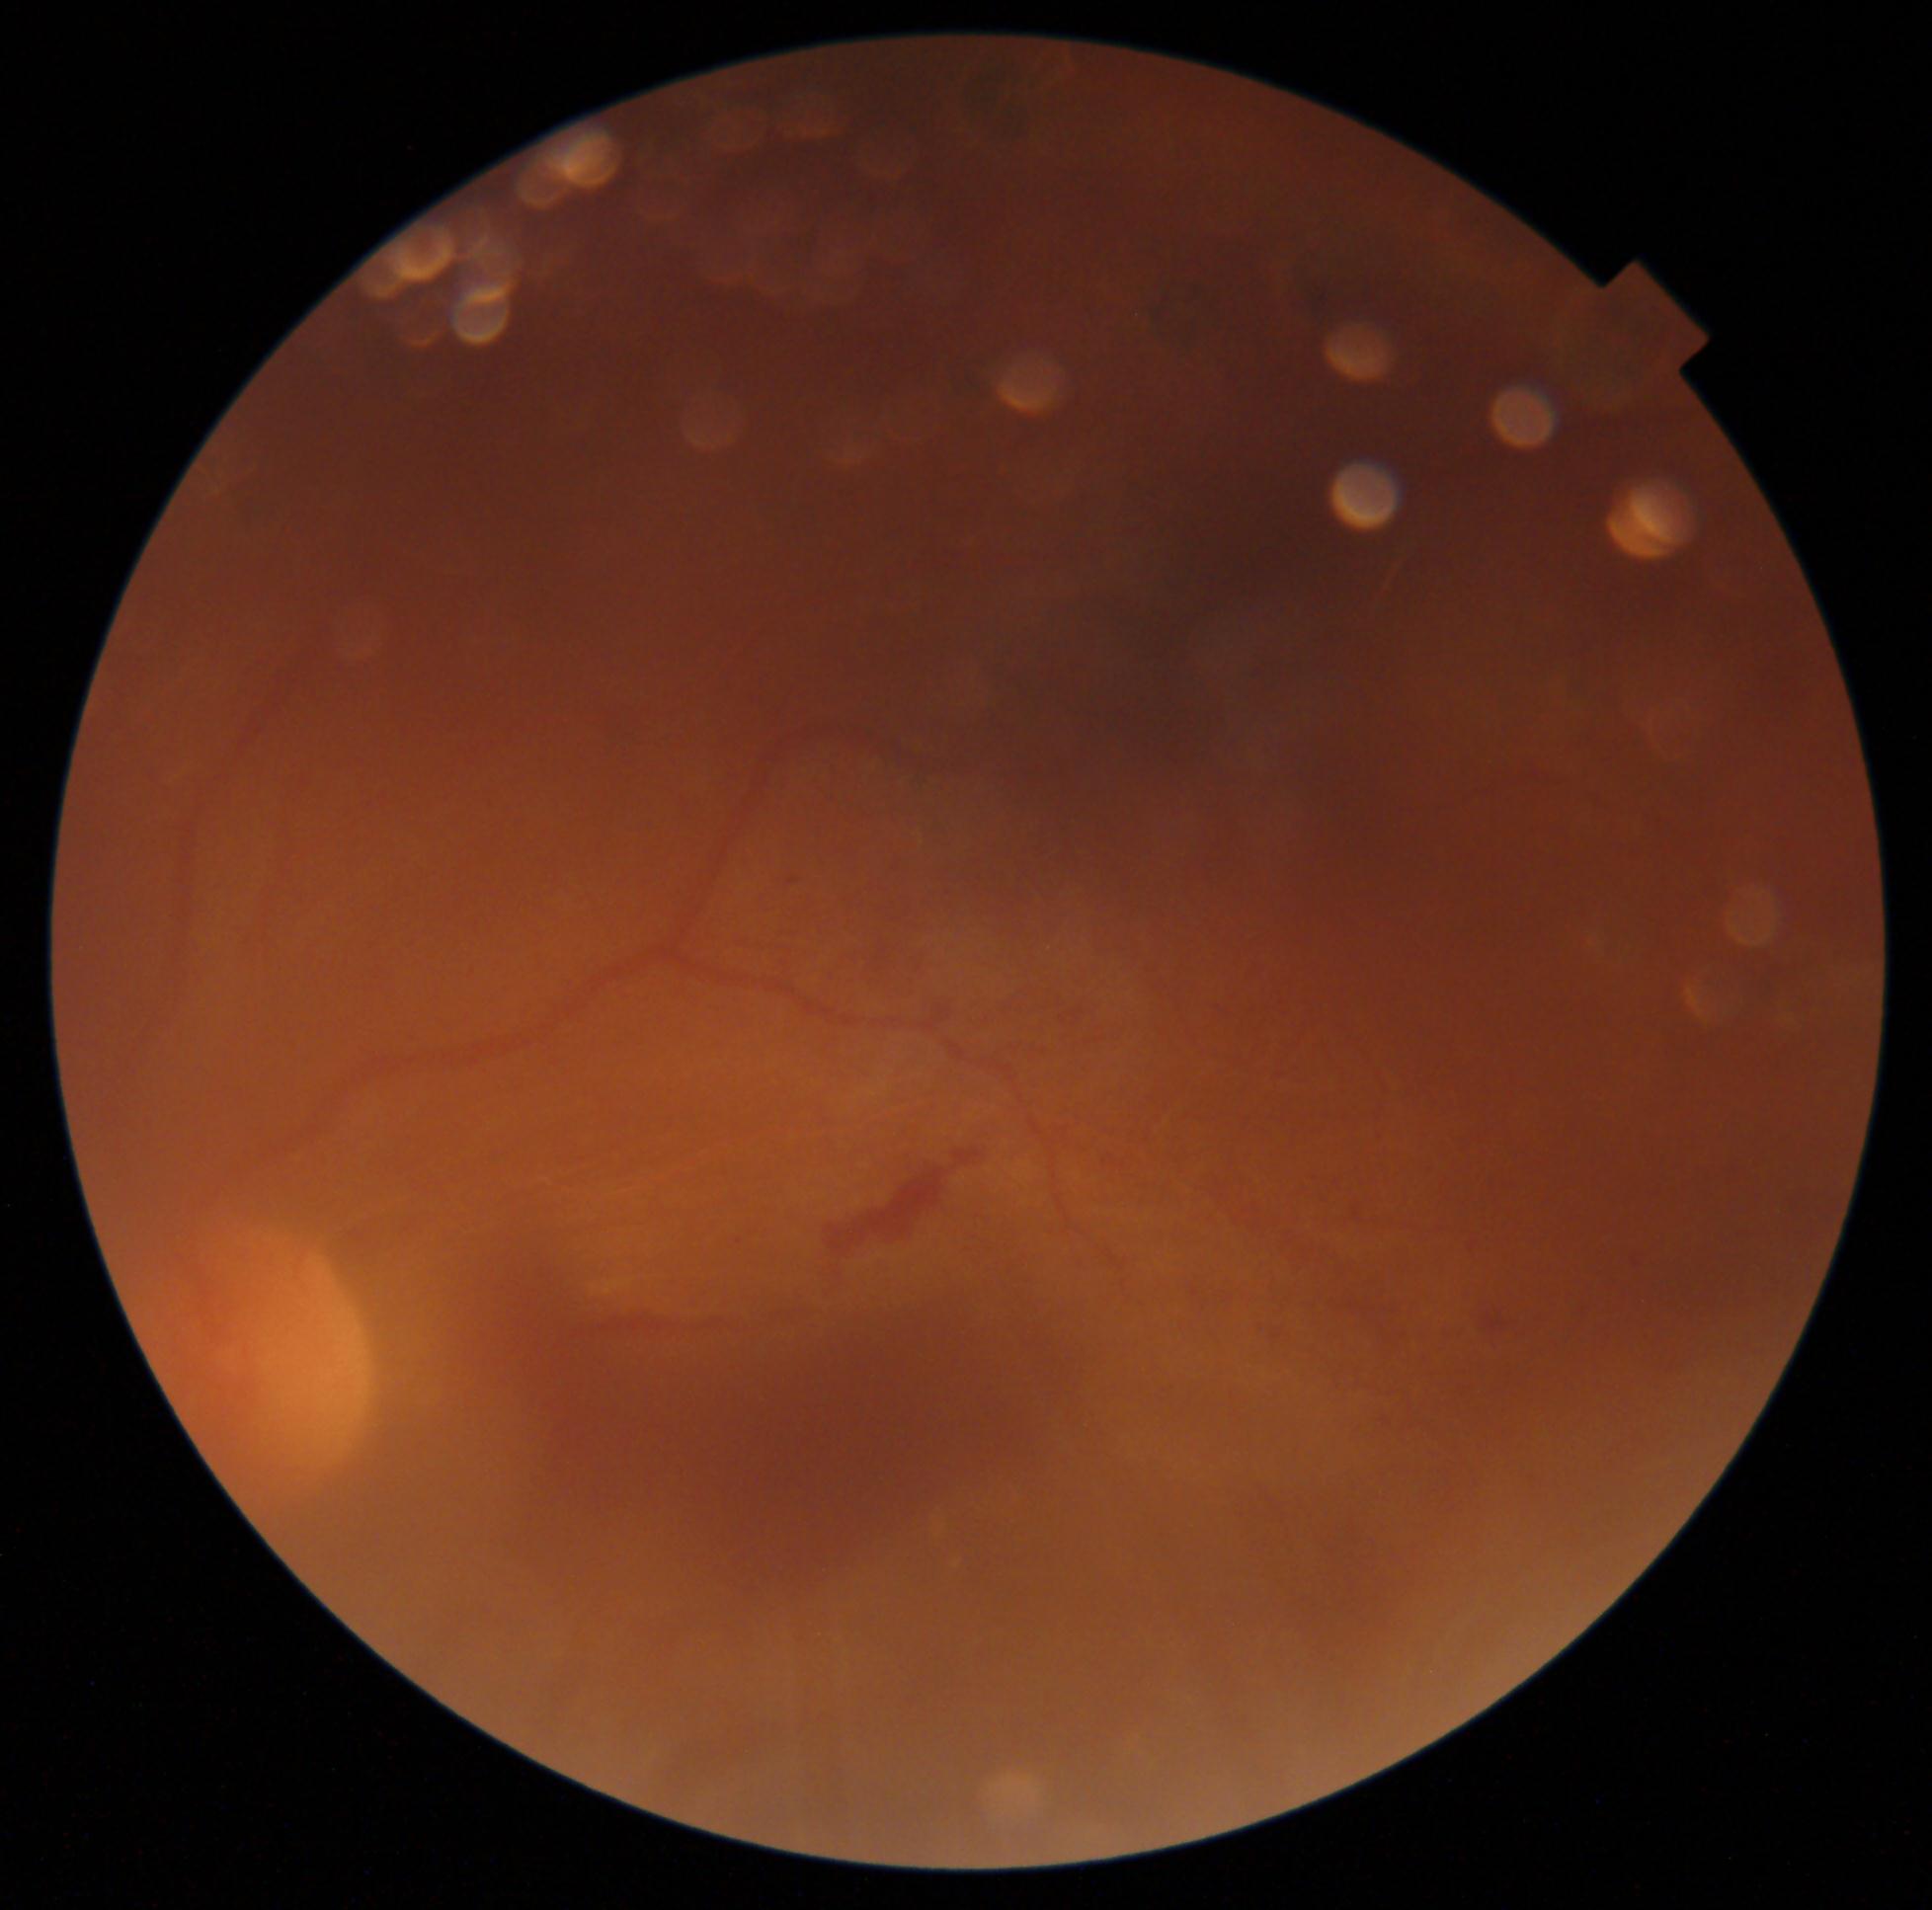

diabetic retinopathy severity=grade 4 (PDR).